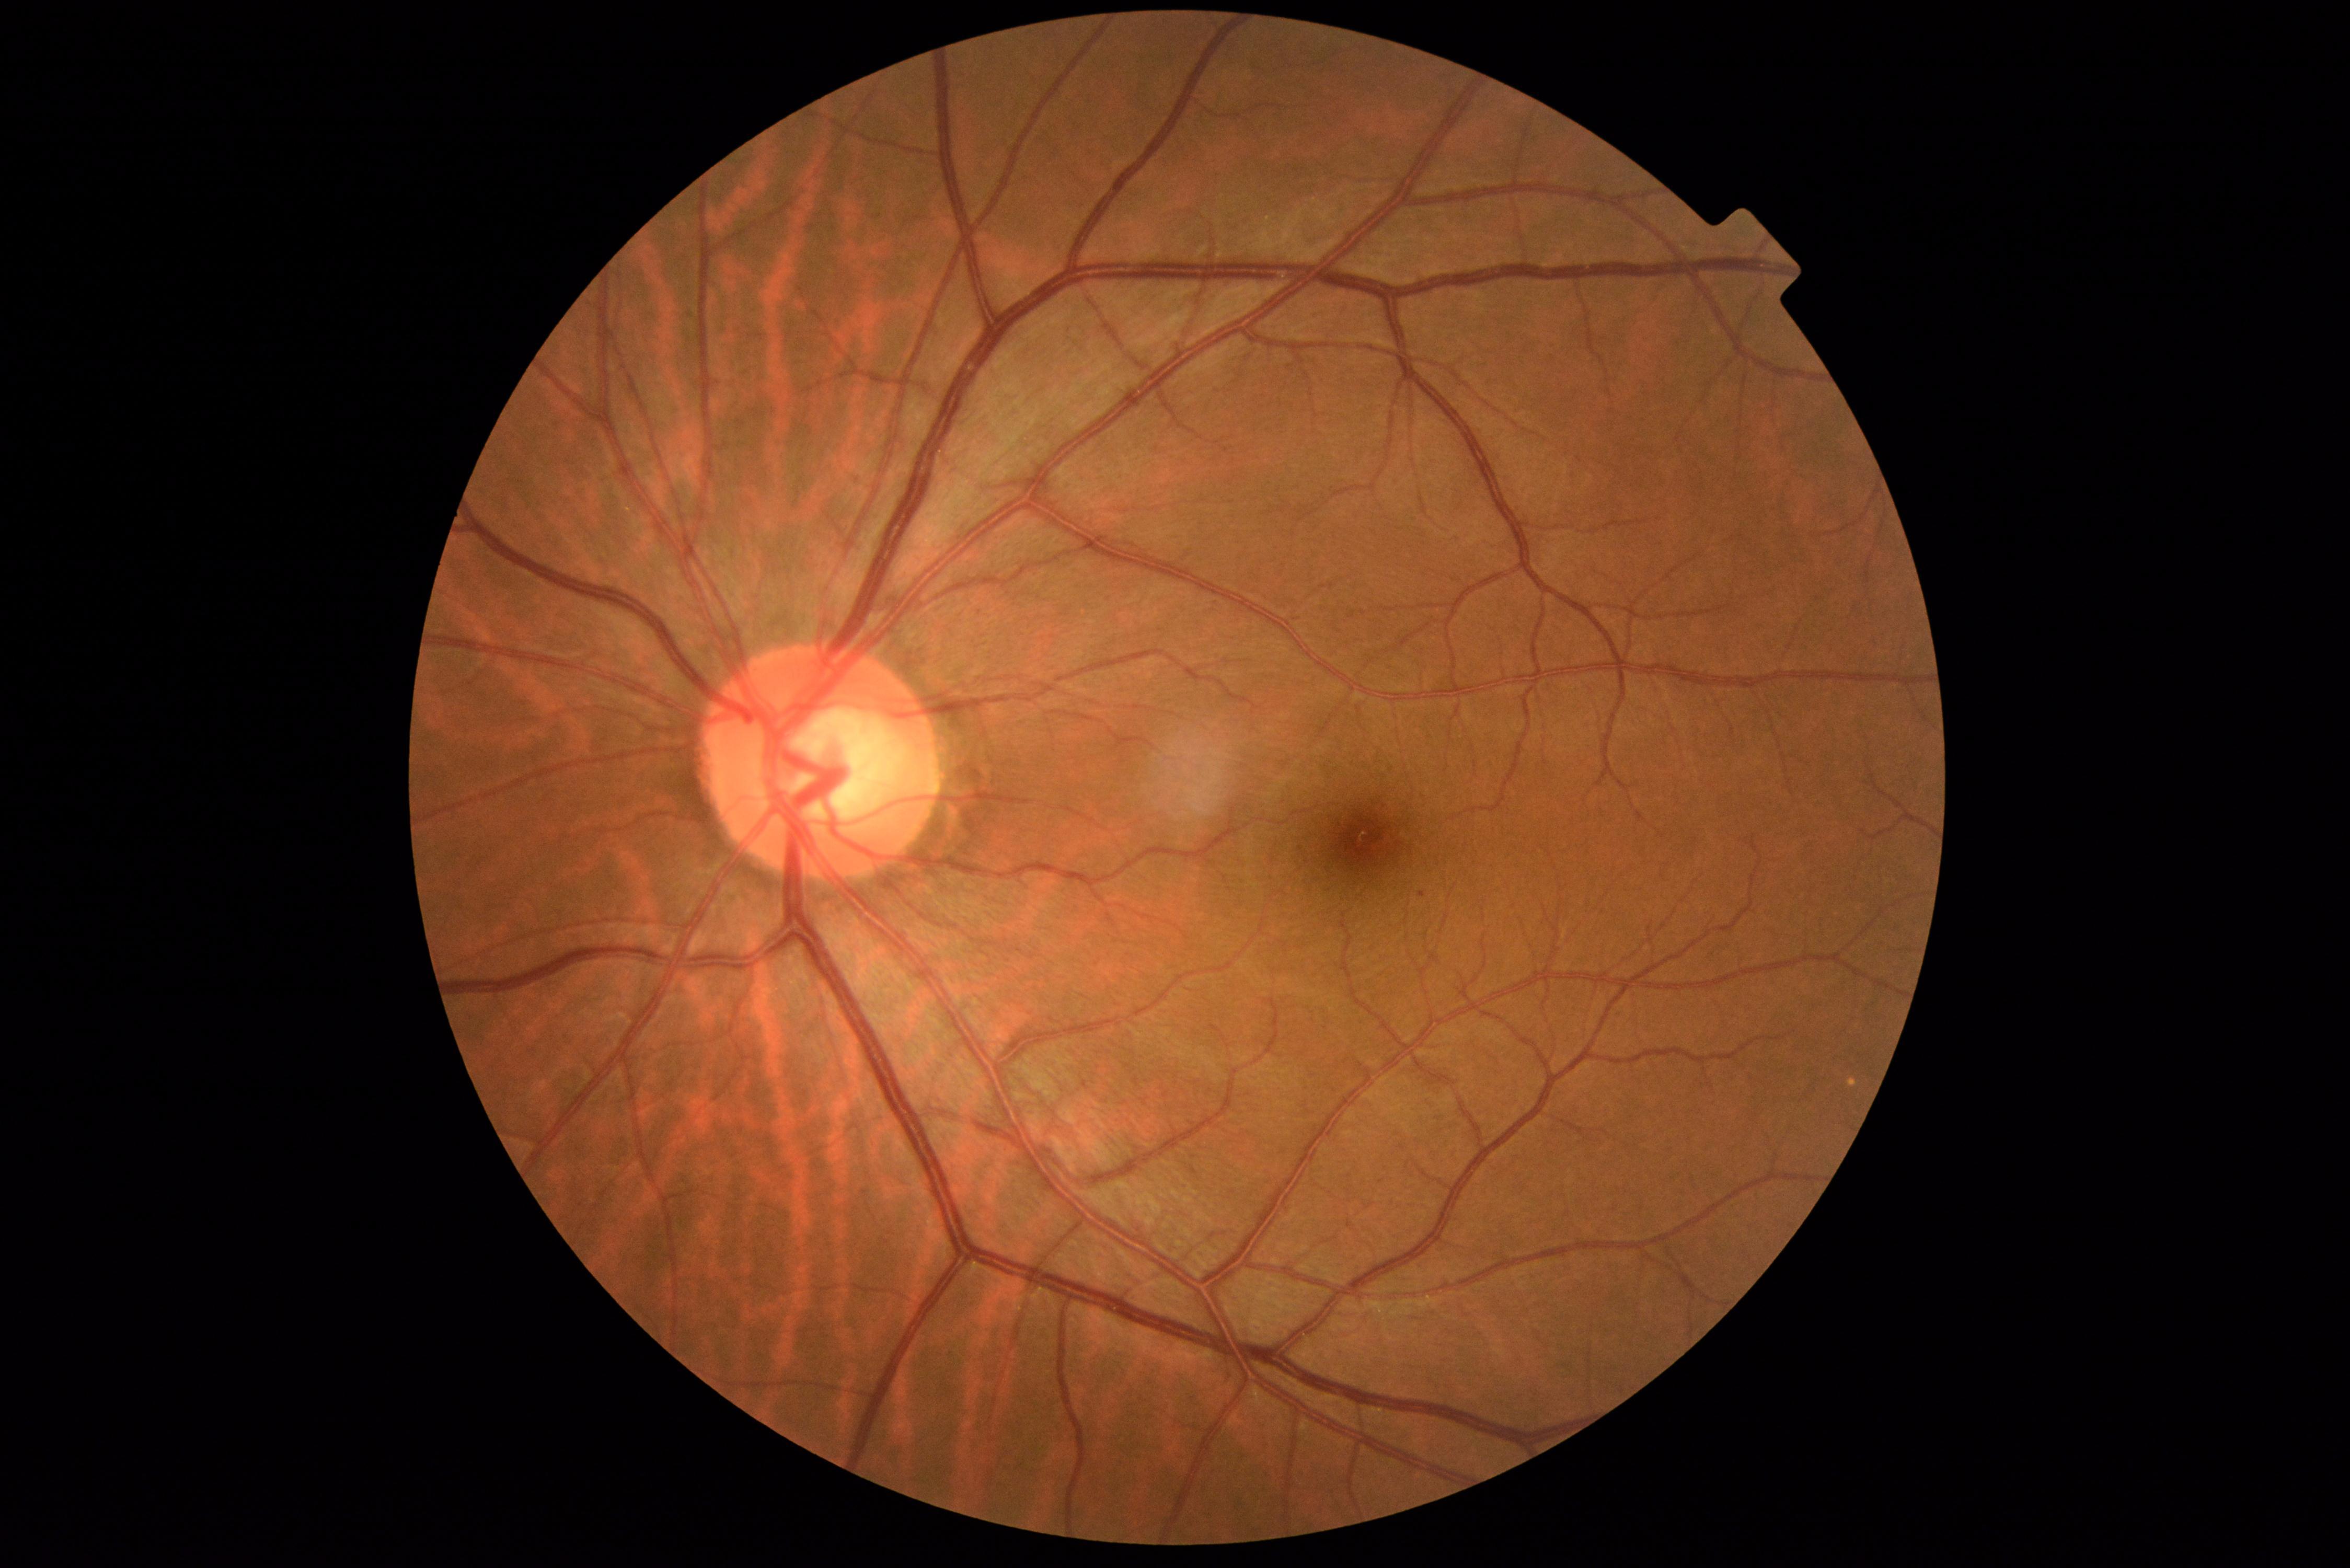 DR severity: 1.